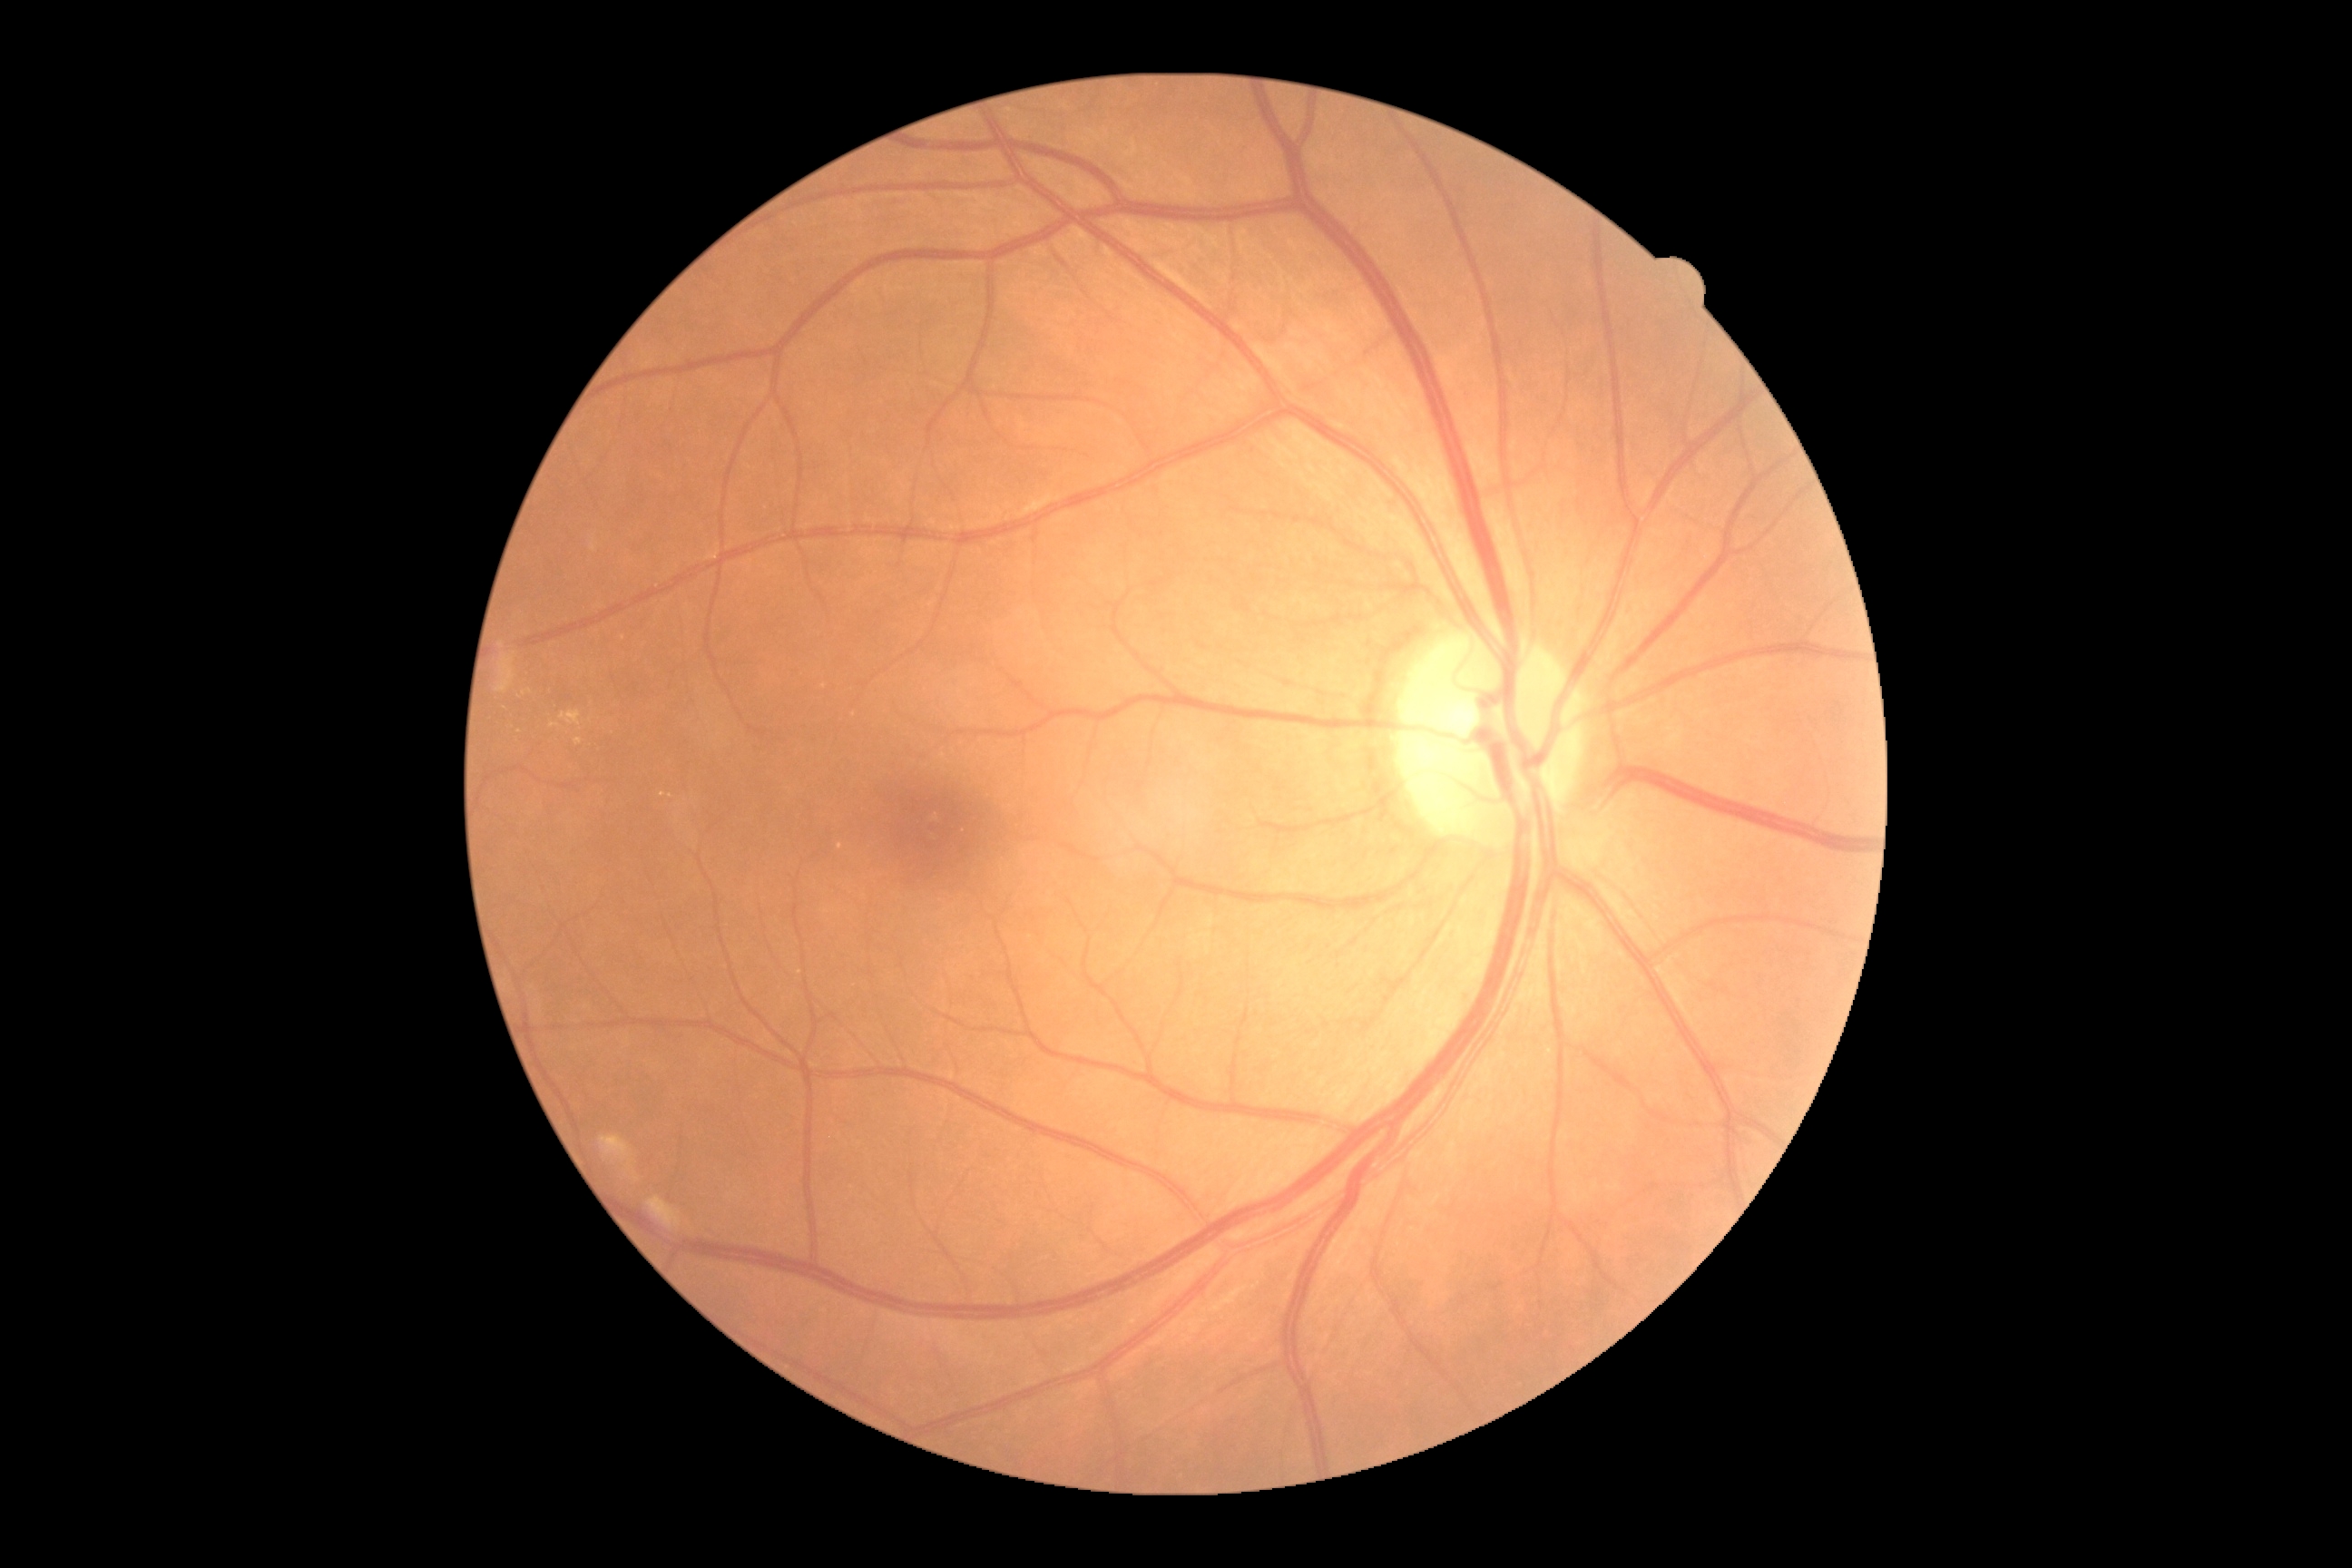 Diabetic retinopathy severity is grade 2.